CFP
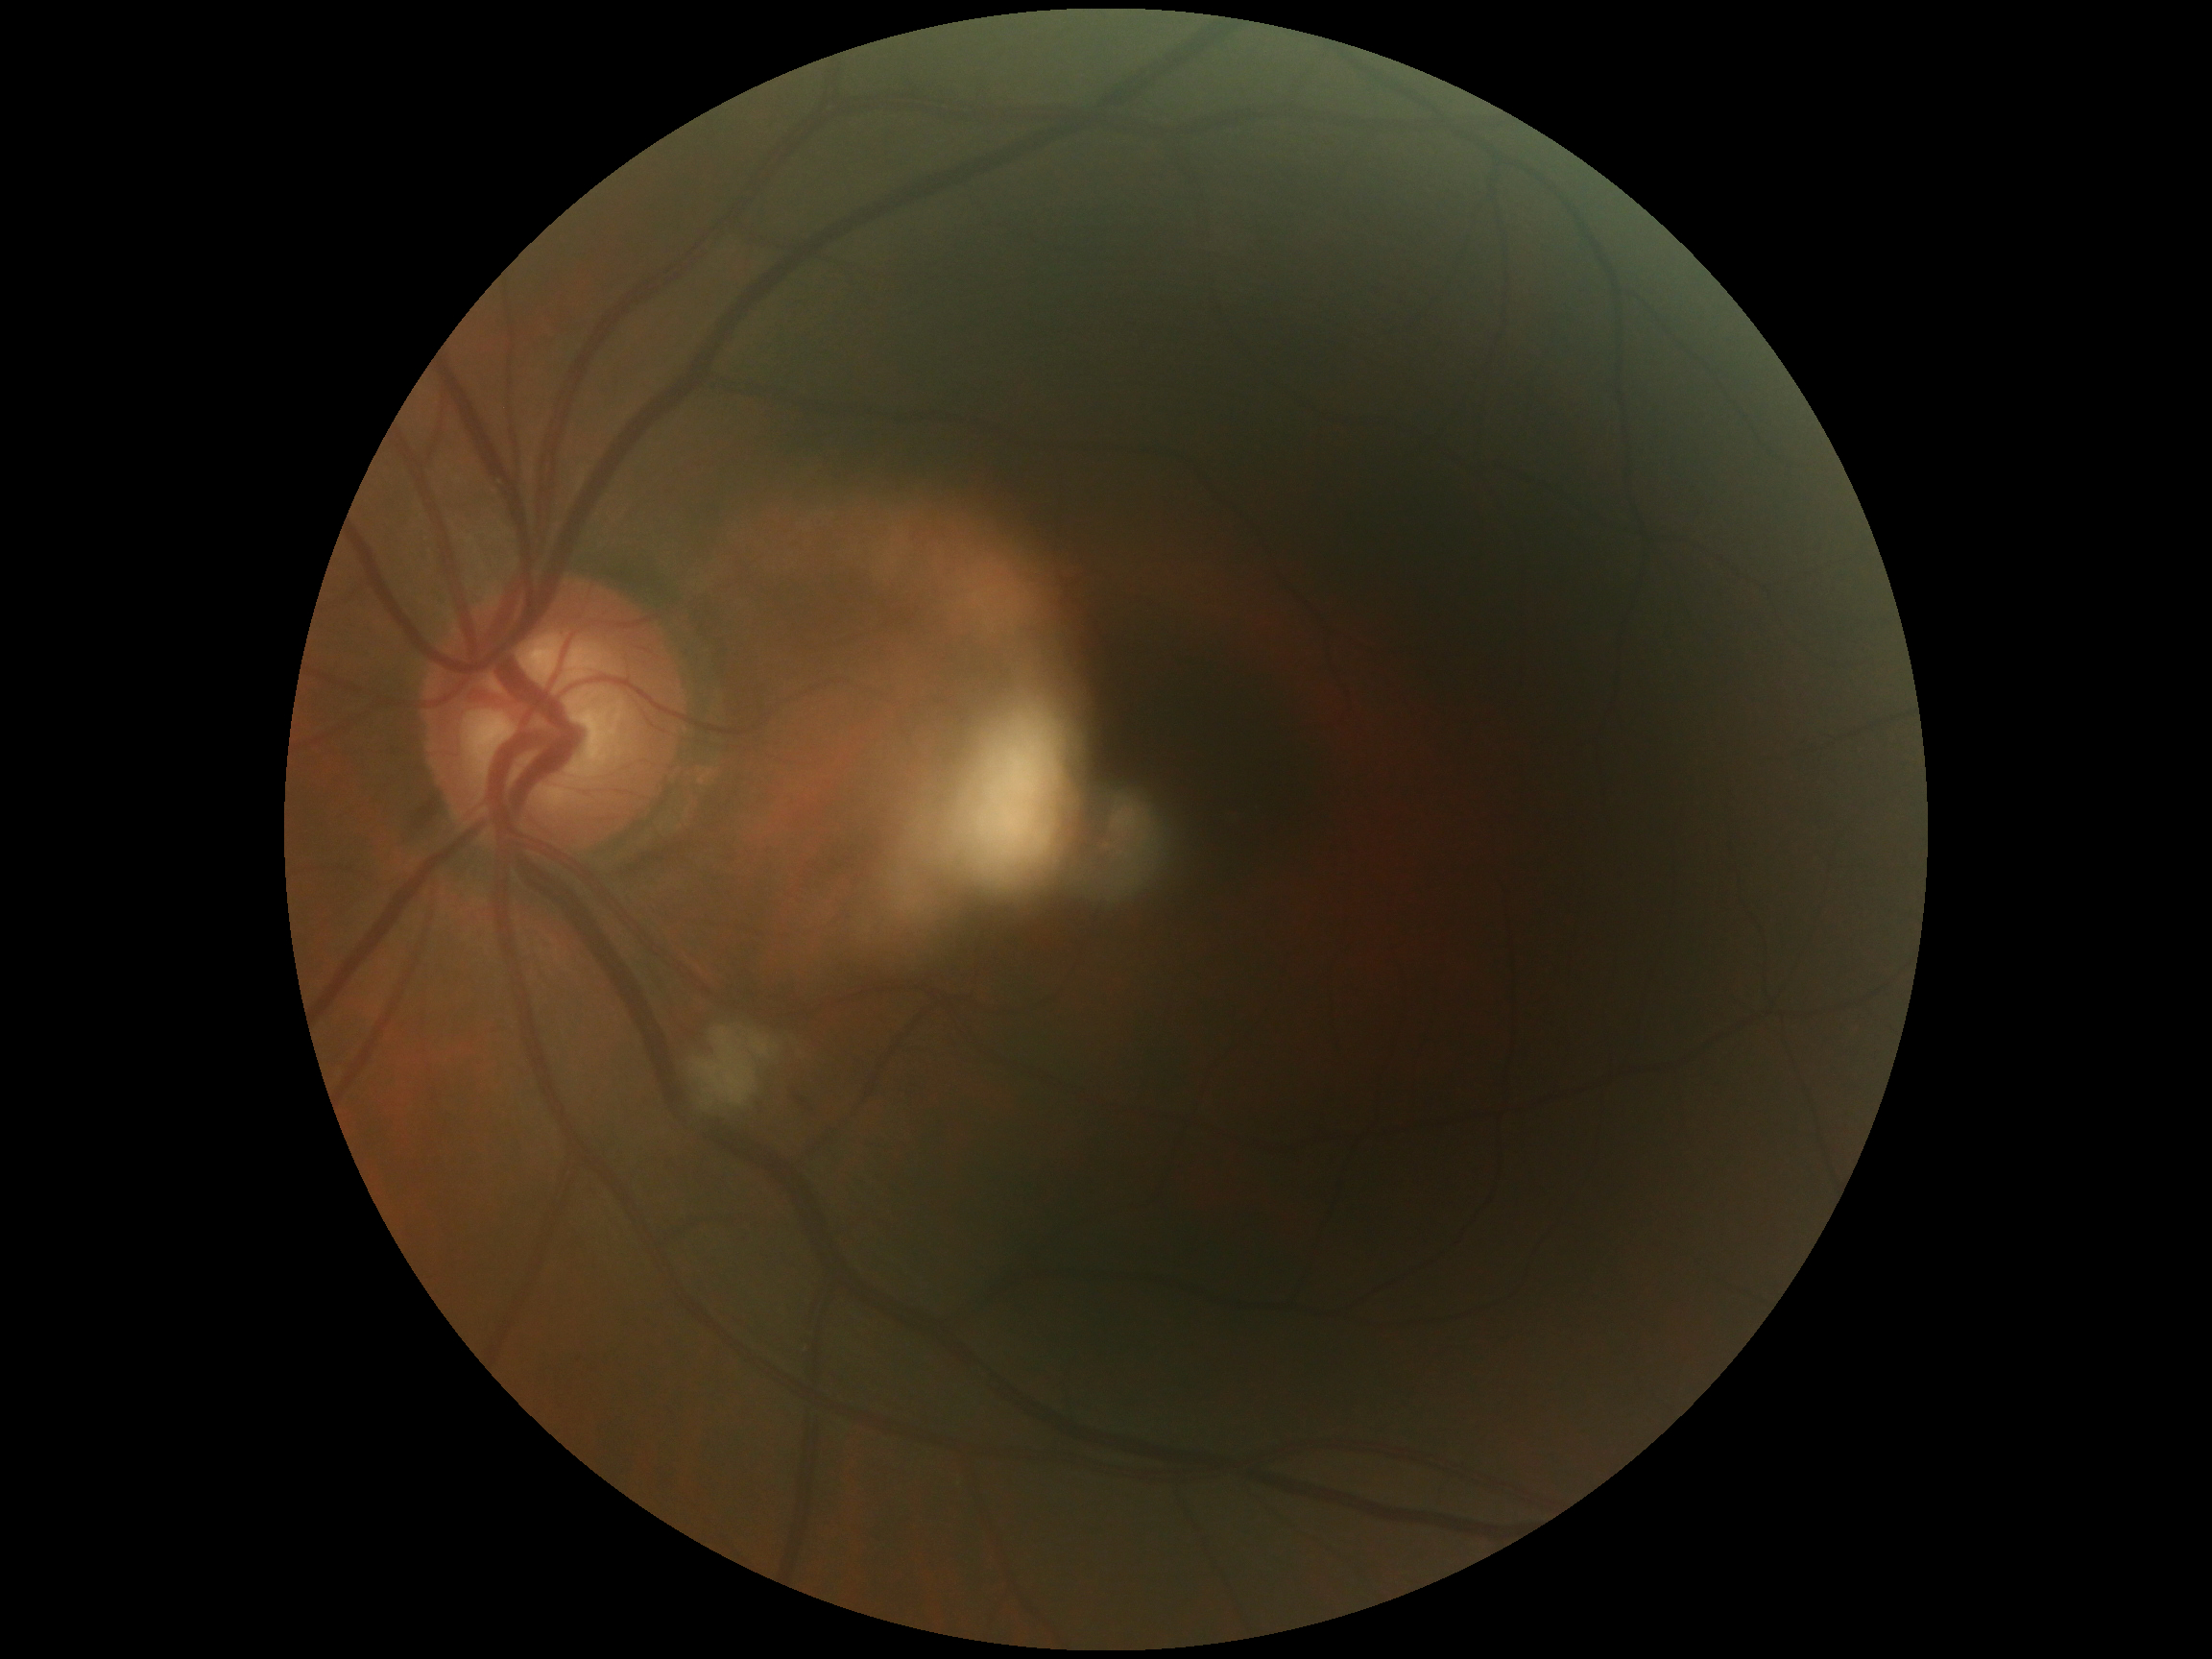 dr_grade: 2/4